Acquired with a NIDEK AFC-230 · 848 x 848 pixels · FOV: 45 degrees · diabetic retinopathy graded by the modified Davis classification · posterior pole photograph:
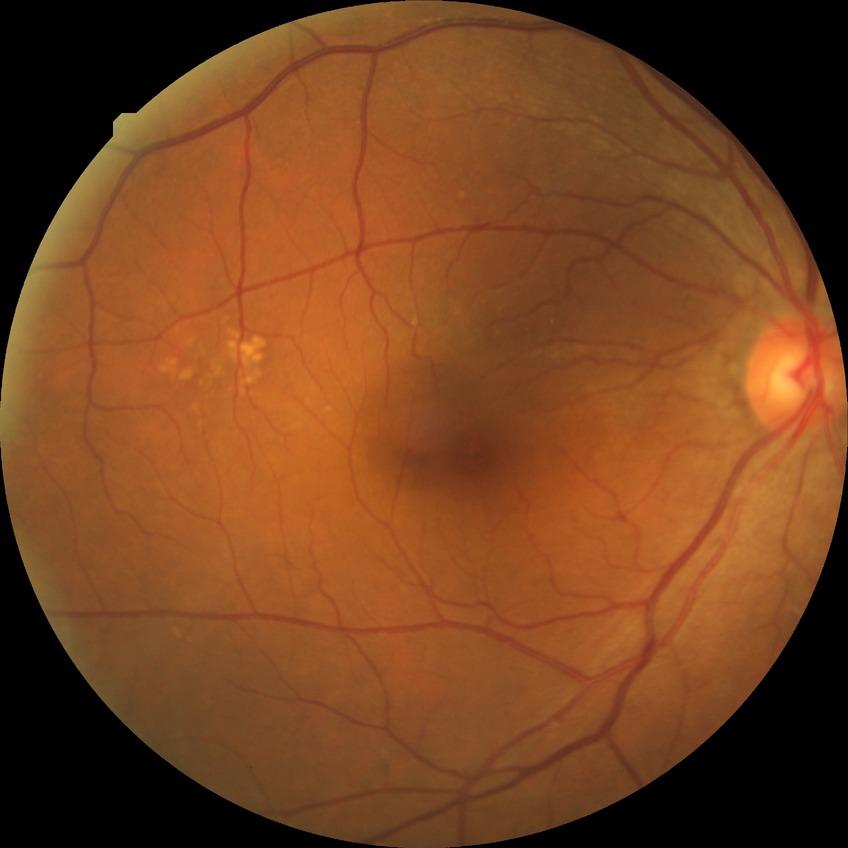

Diabetic retinopathy (DR): NDR (no diabetic retinopathy).